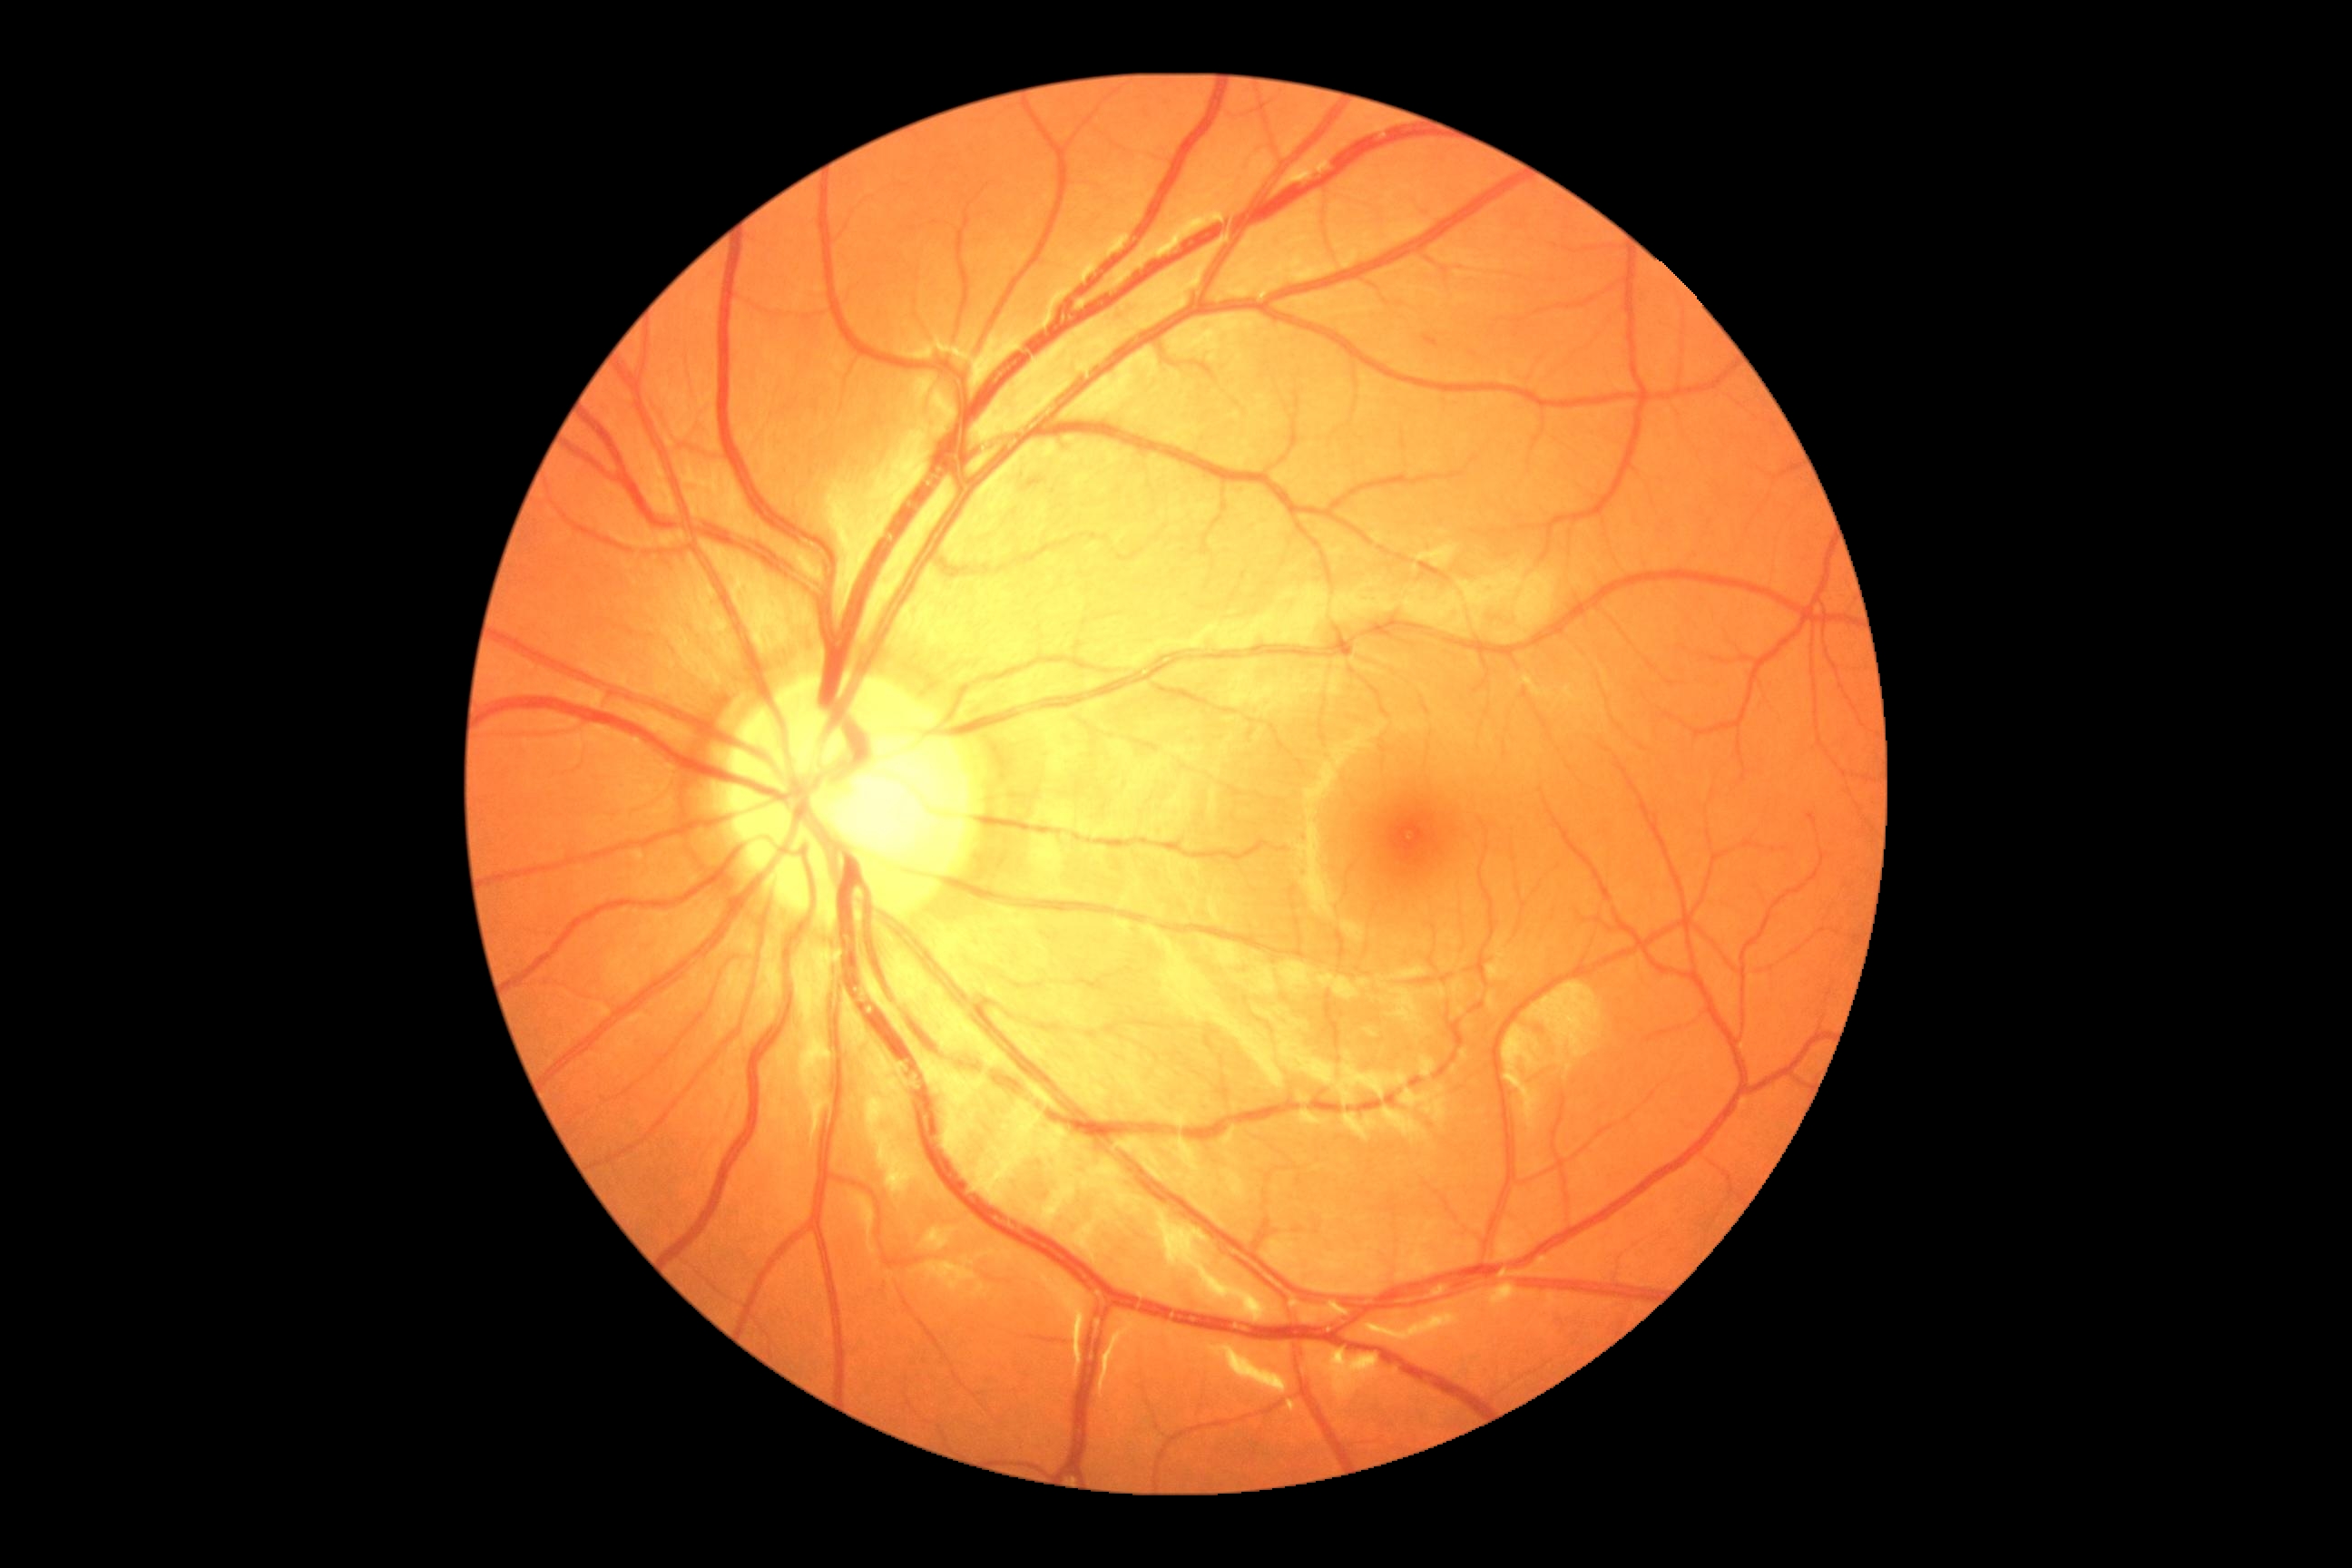 diabetic retinopathy grade: 1.